Pediatric retinal photograph (wide-field) · acquired on the Clarity RetCam 3:
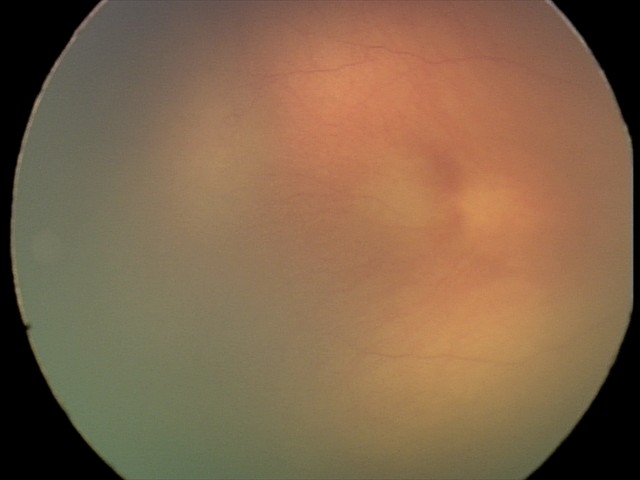

Screening diagnosis: no plus disease; retinopathy of prematurity (ROP) stage 0 — incomplete retinal vascularization without a demarcation line.